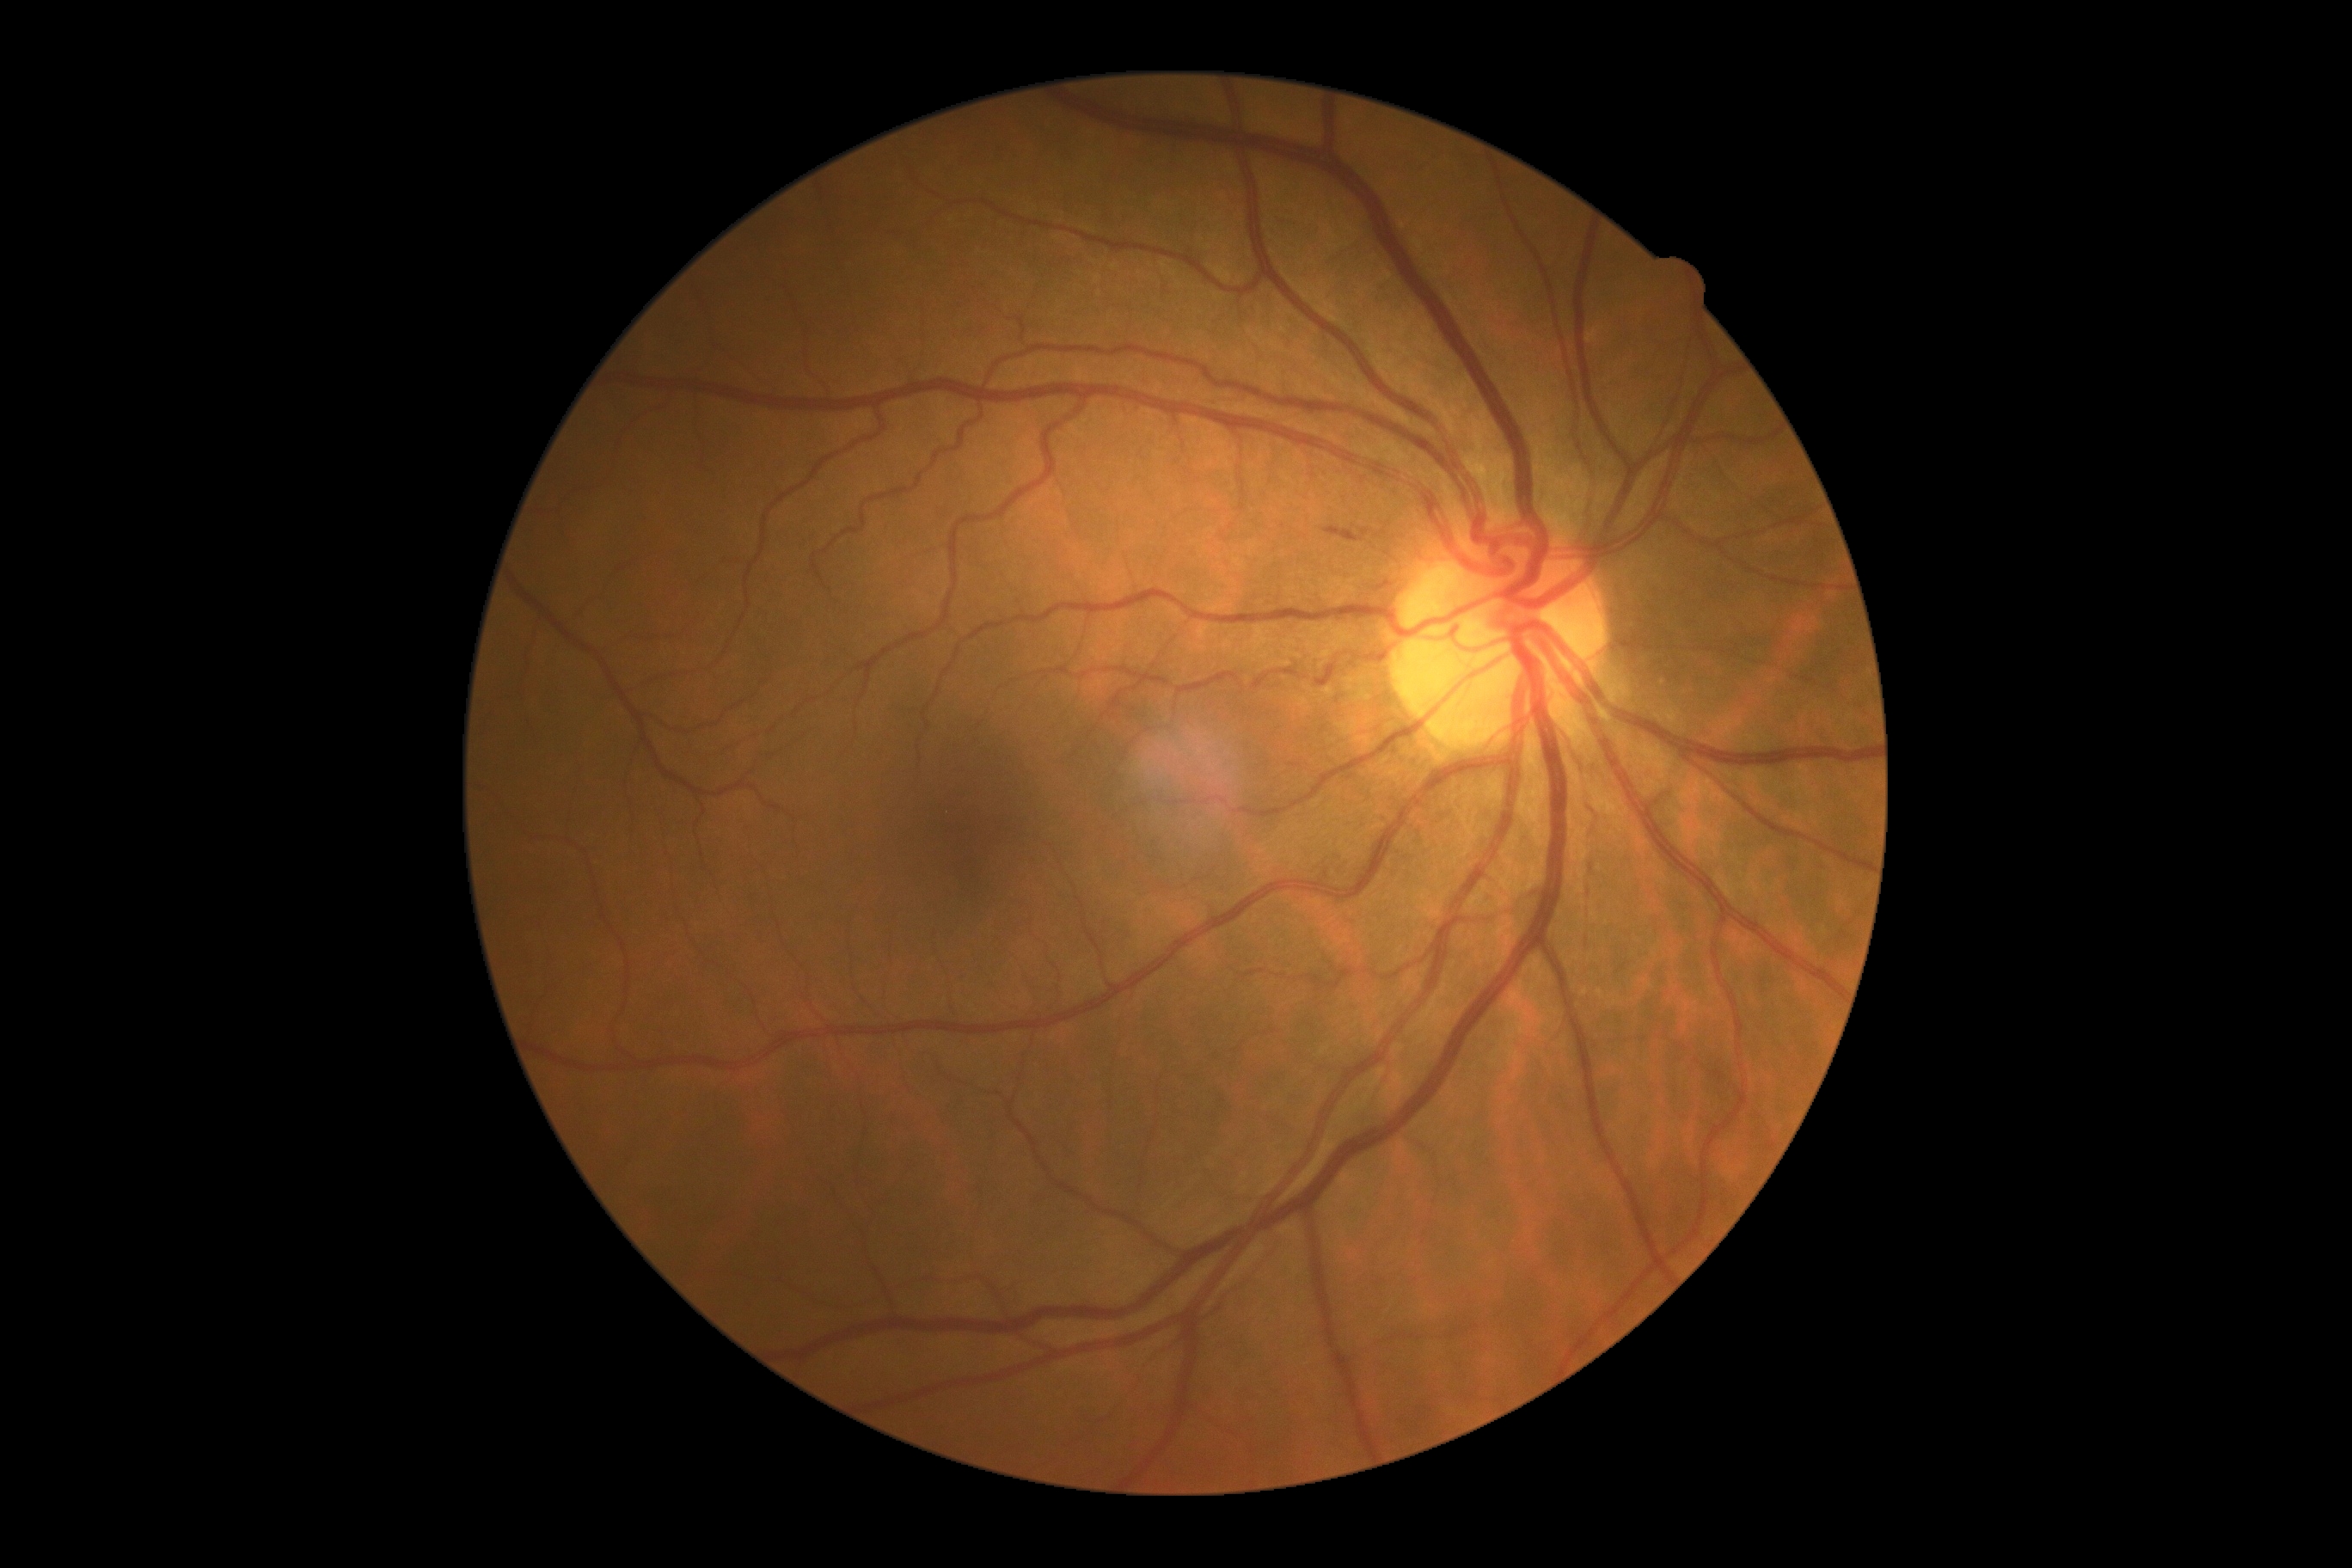 Diabetic retinopathy grade: 2/4.